2352 by 1568 pixels, 45-degree field of view.
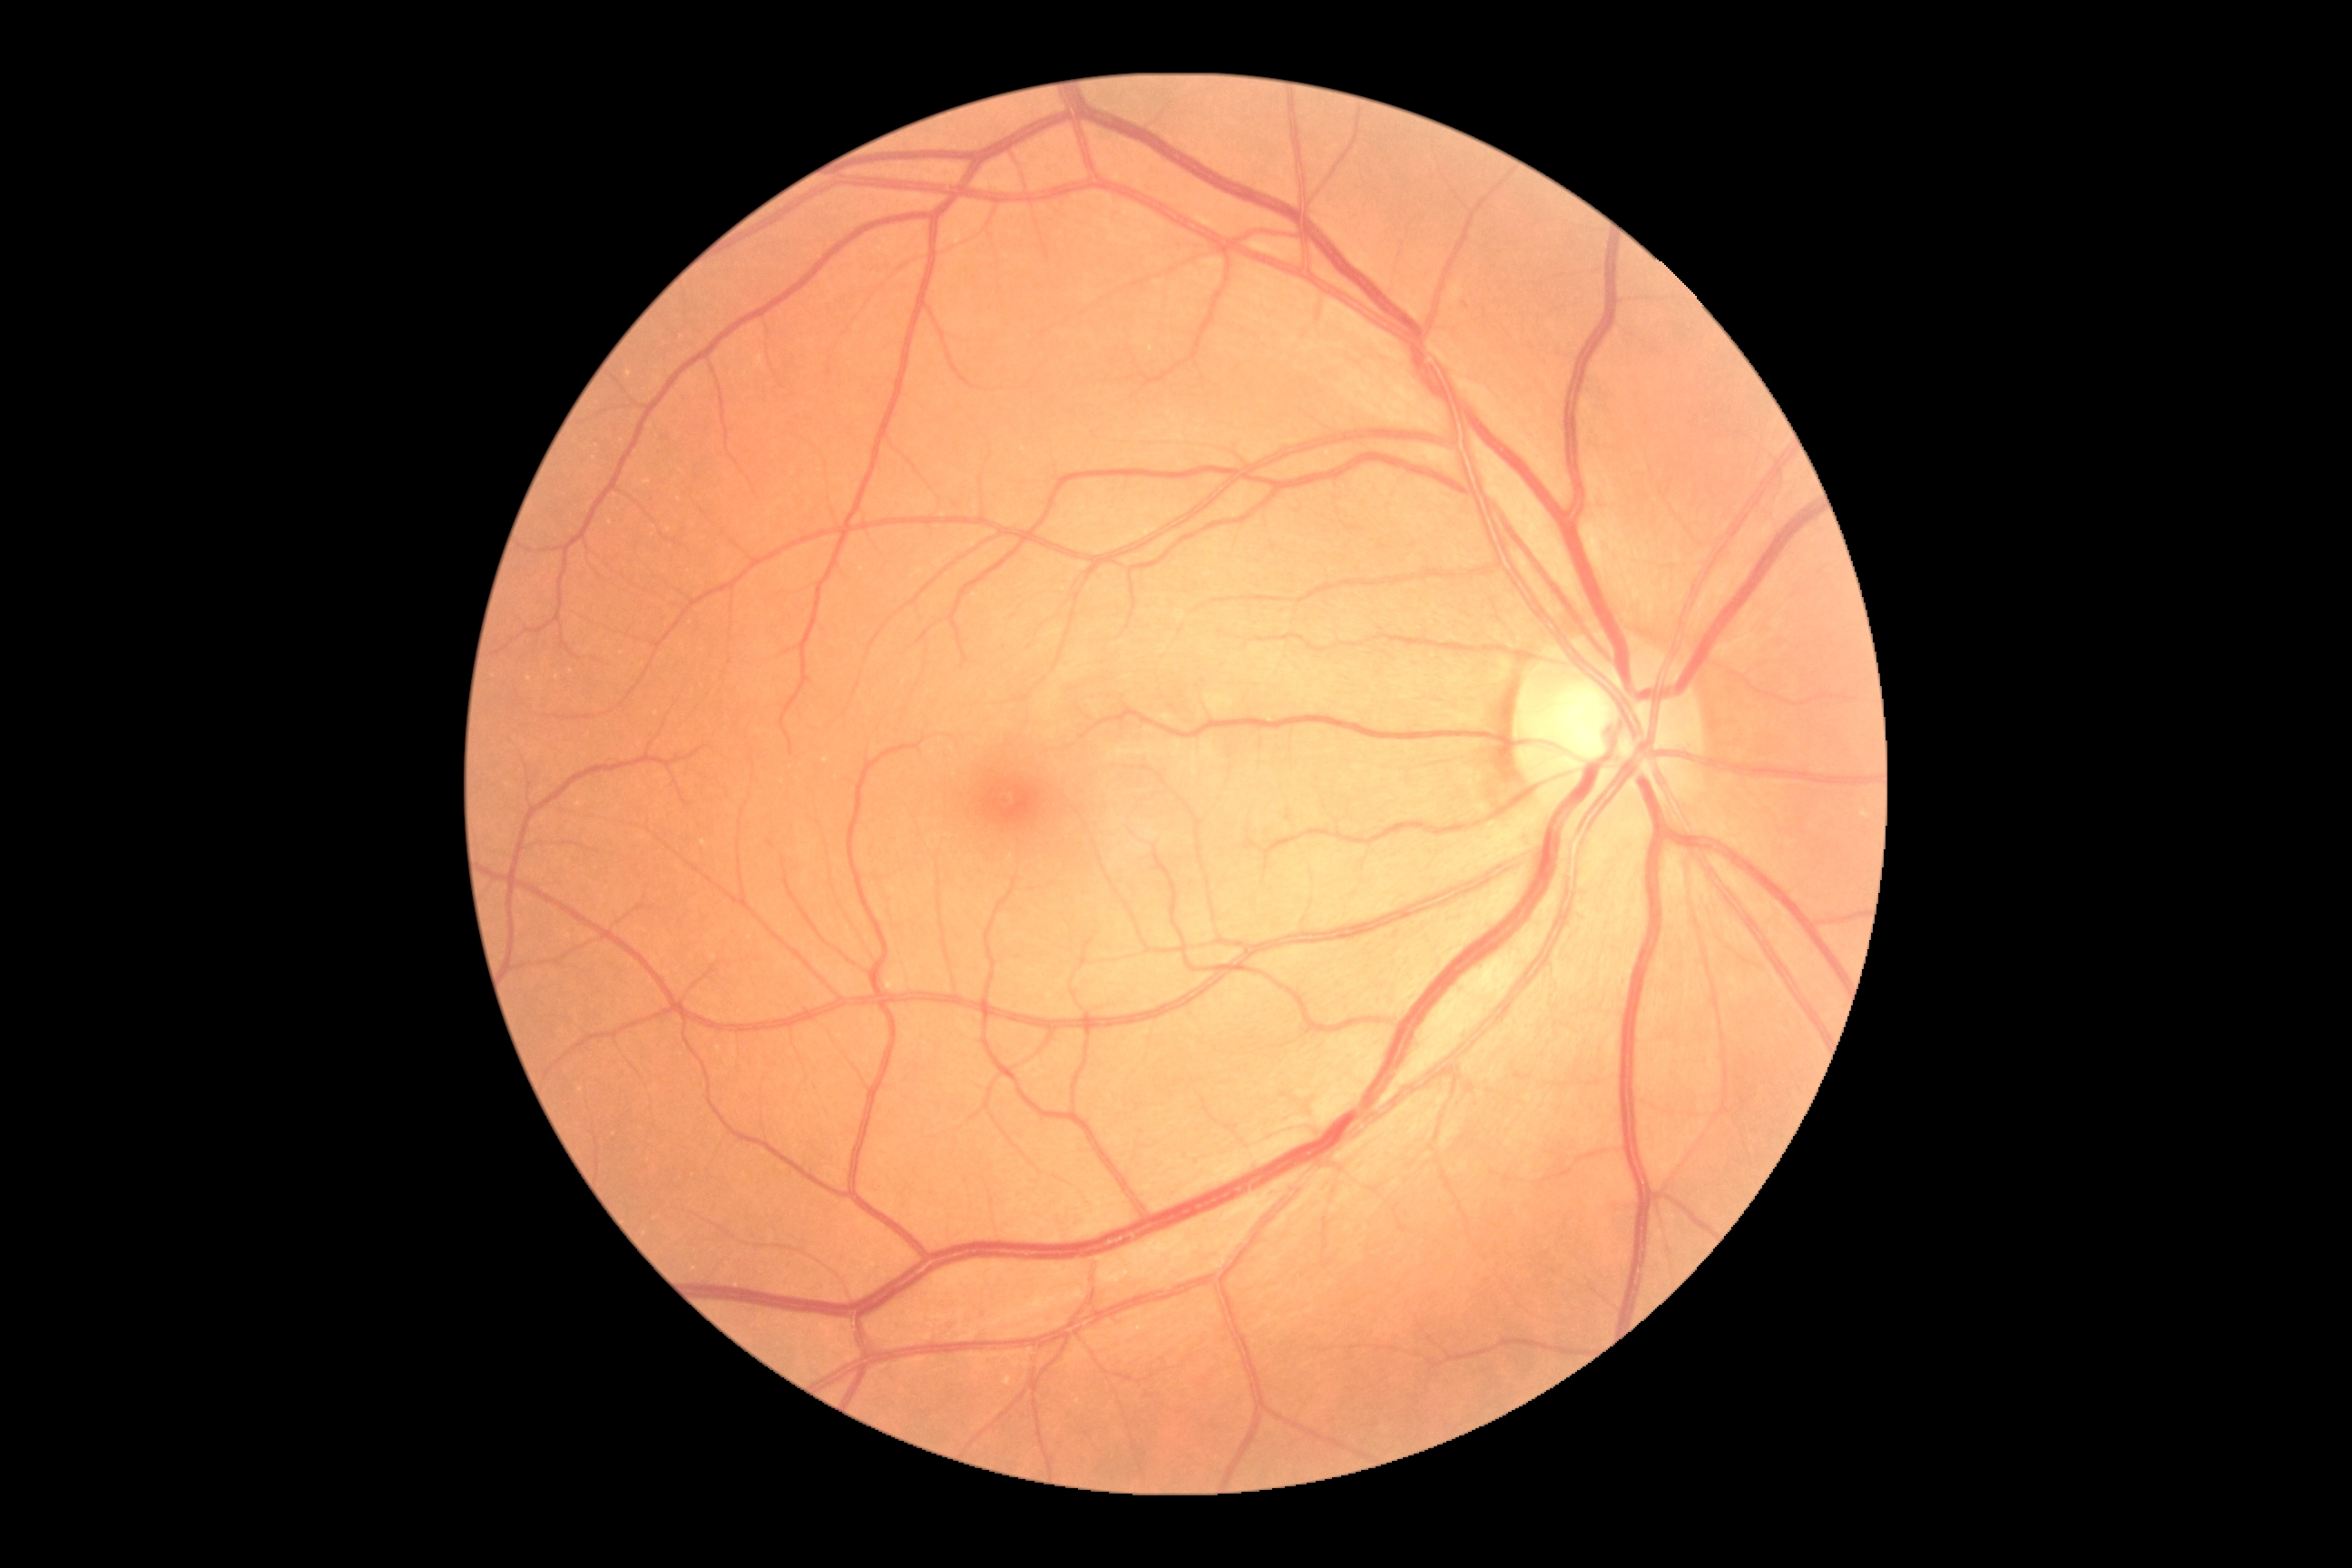
diabetic retinopathy (DR): 0/4.